Dilated-pupil acquisition: 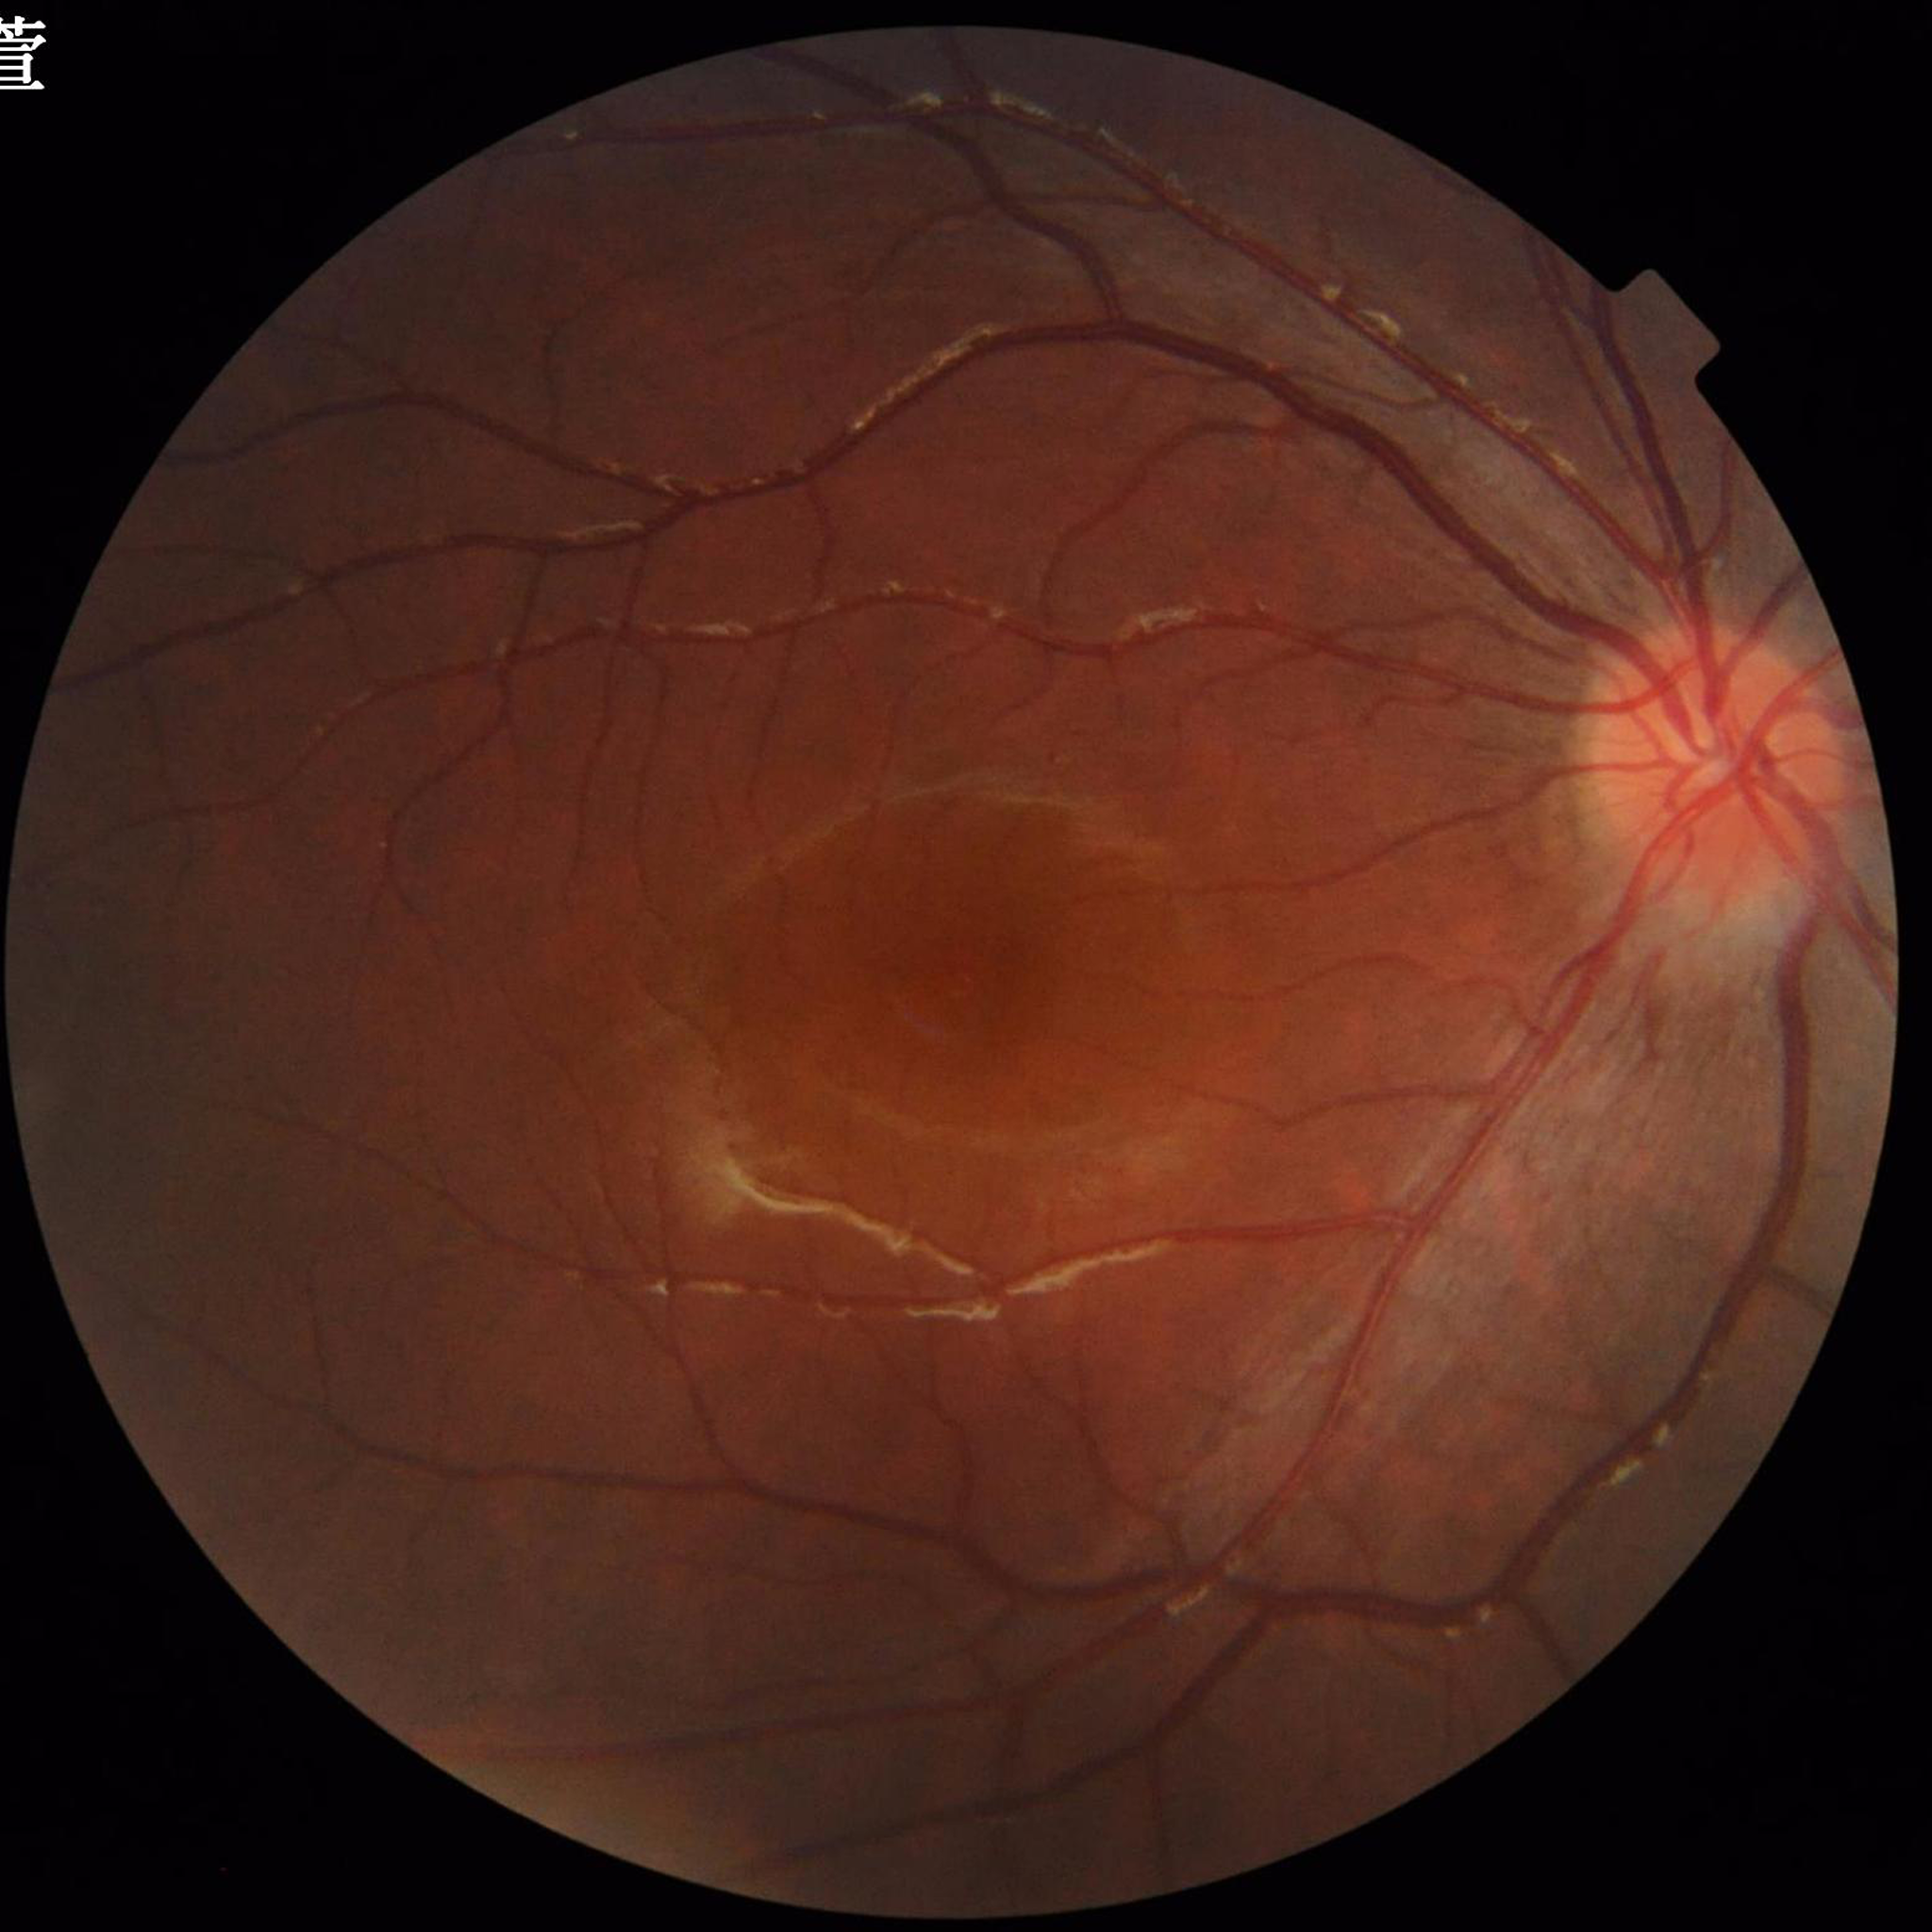

Quality: adequate
Impression: control (no AMD/DR/glaucoma)